Nonmydriatic; NIDEK AFC-230; fundus photo.
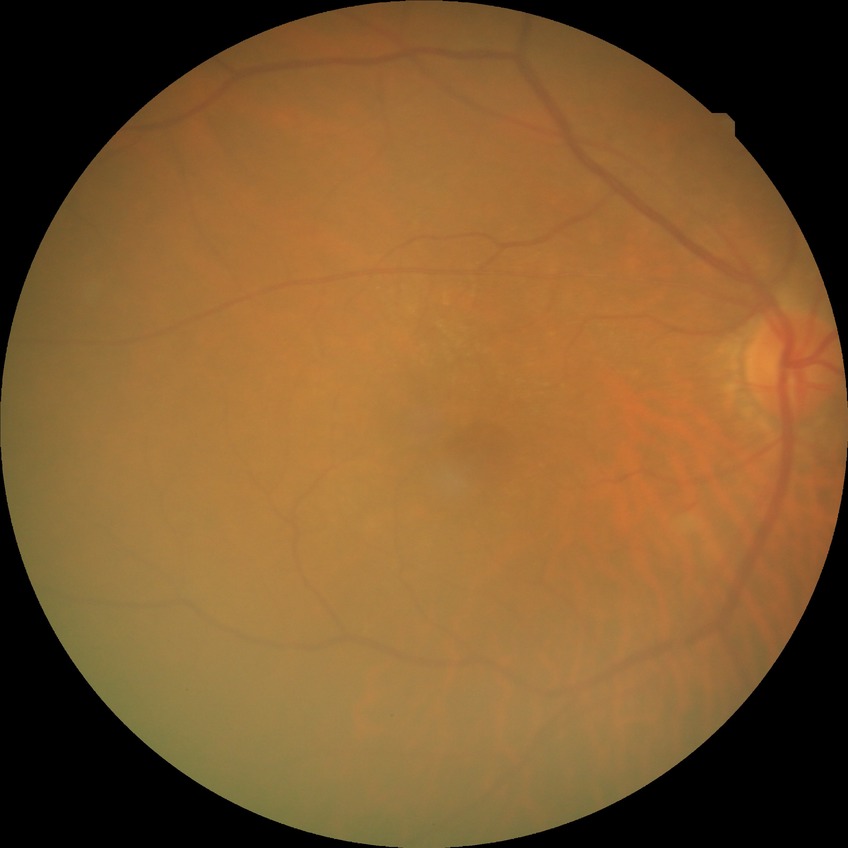
Diabetic retinopathy (DR): NDR (no diabetic retinopathy).